Wide-field fundus photograph from neonatal ROP screening · acquired on the Phoenix ICON
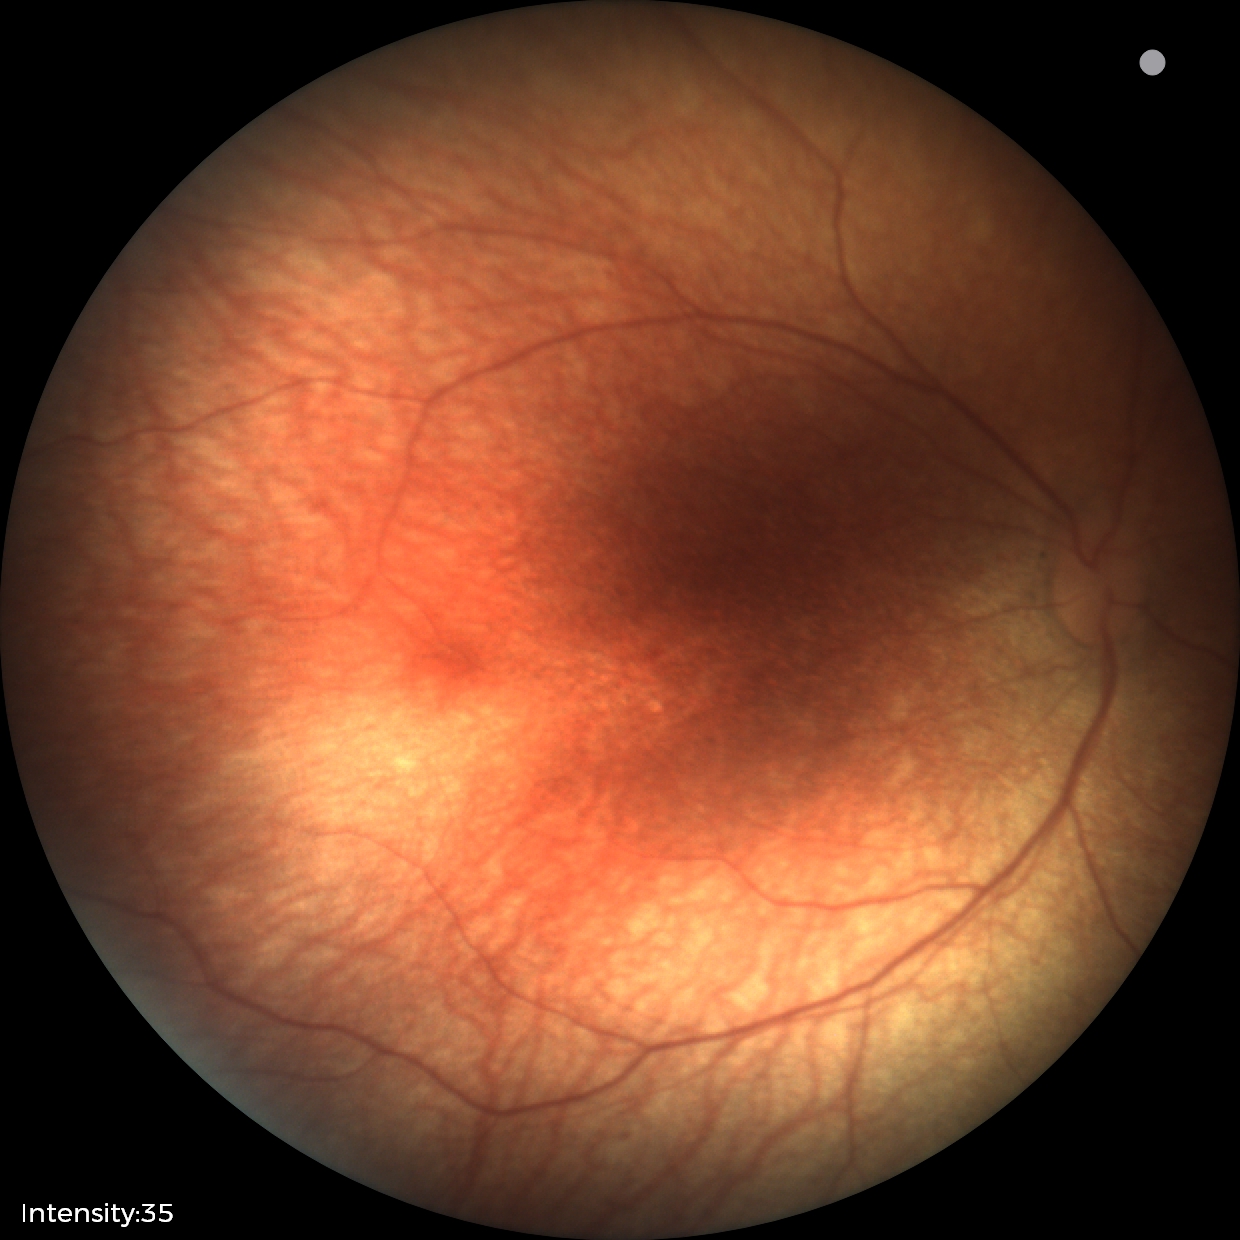

Q: What was the screening finding?
A: physiological appearance with no retinal pathology